Wide-field contact fundus photograph of an infant · Phoenix ICON, 100° FOV
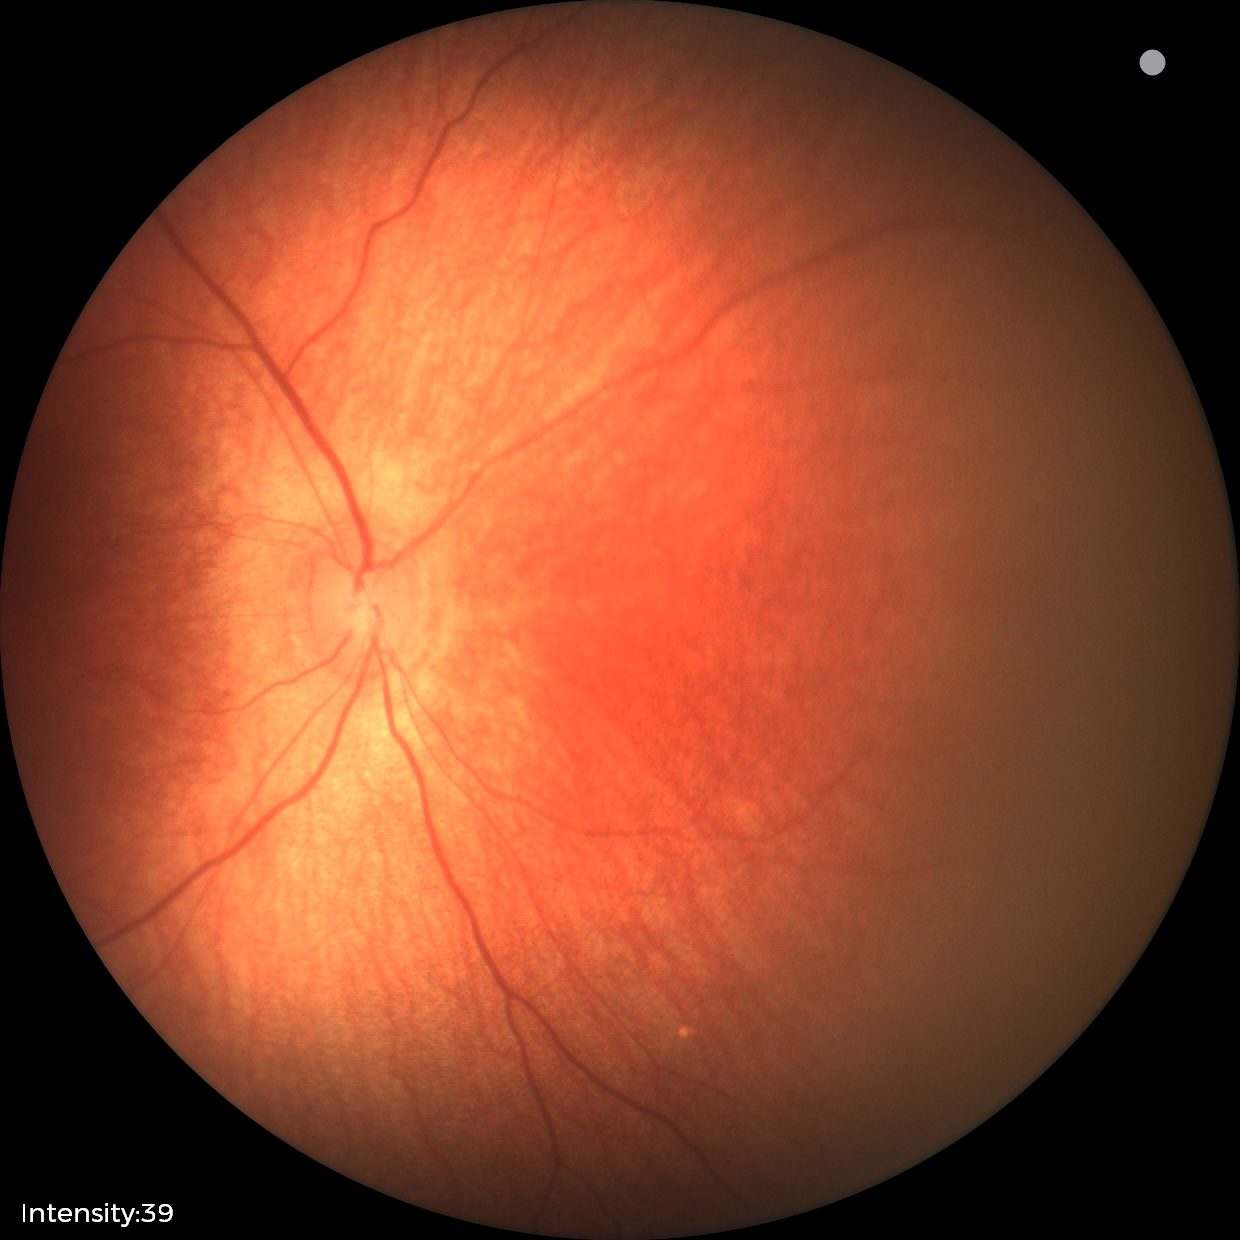

Physiological retinal appearance for postconceptual age.